NIDEK AFC-230 fundus camera.
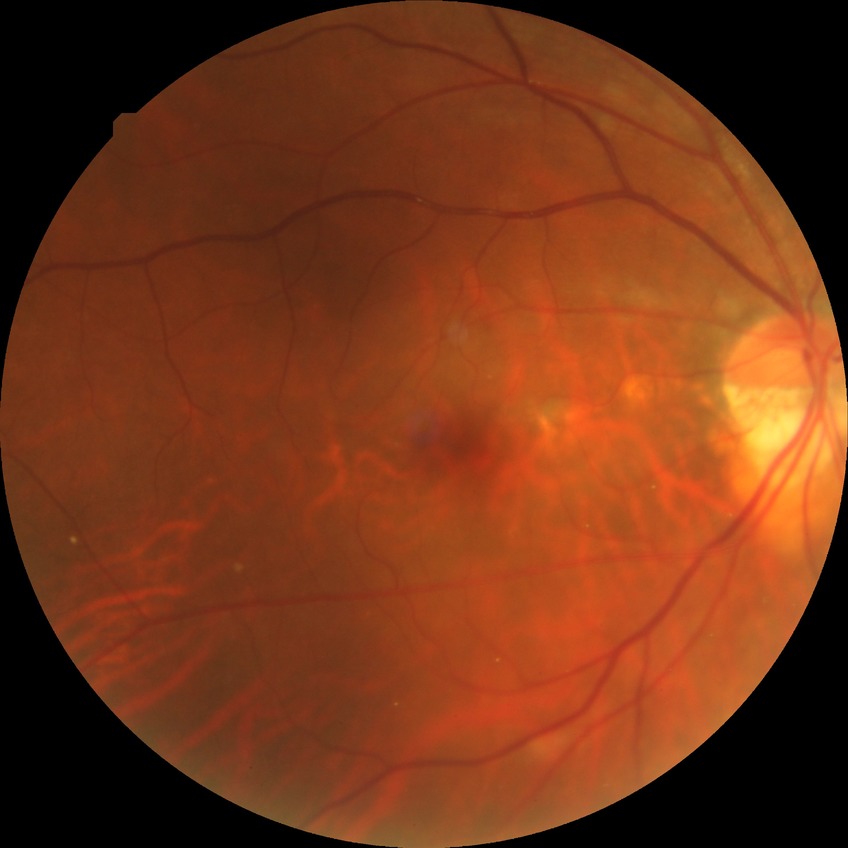 Diabetic retinopathy (DR): PPDR (pre-proliferative diabetic retinopathy). Disease class: non-proliferative diabetic retinopathy.